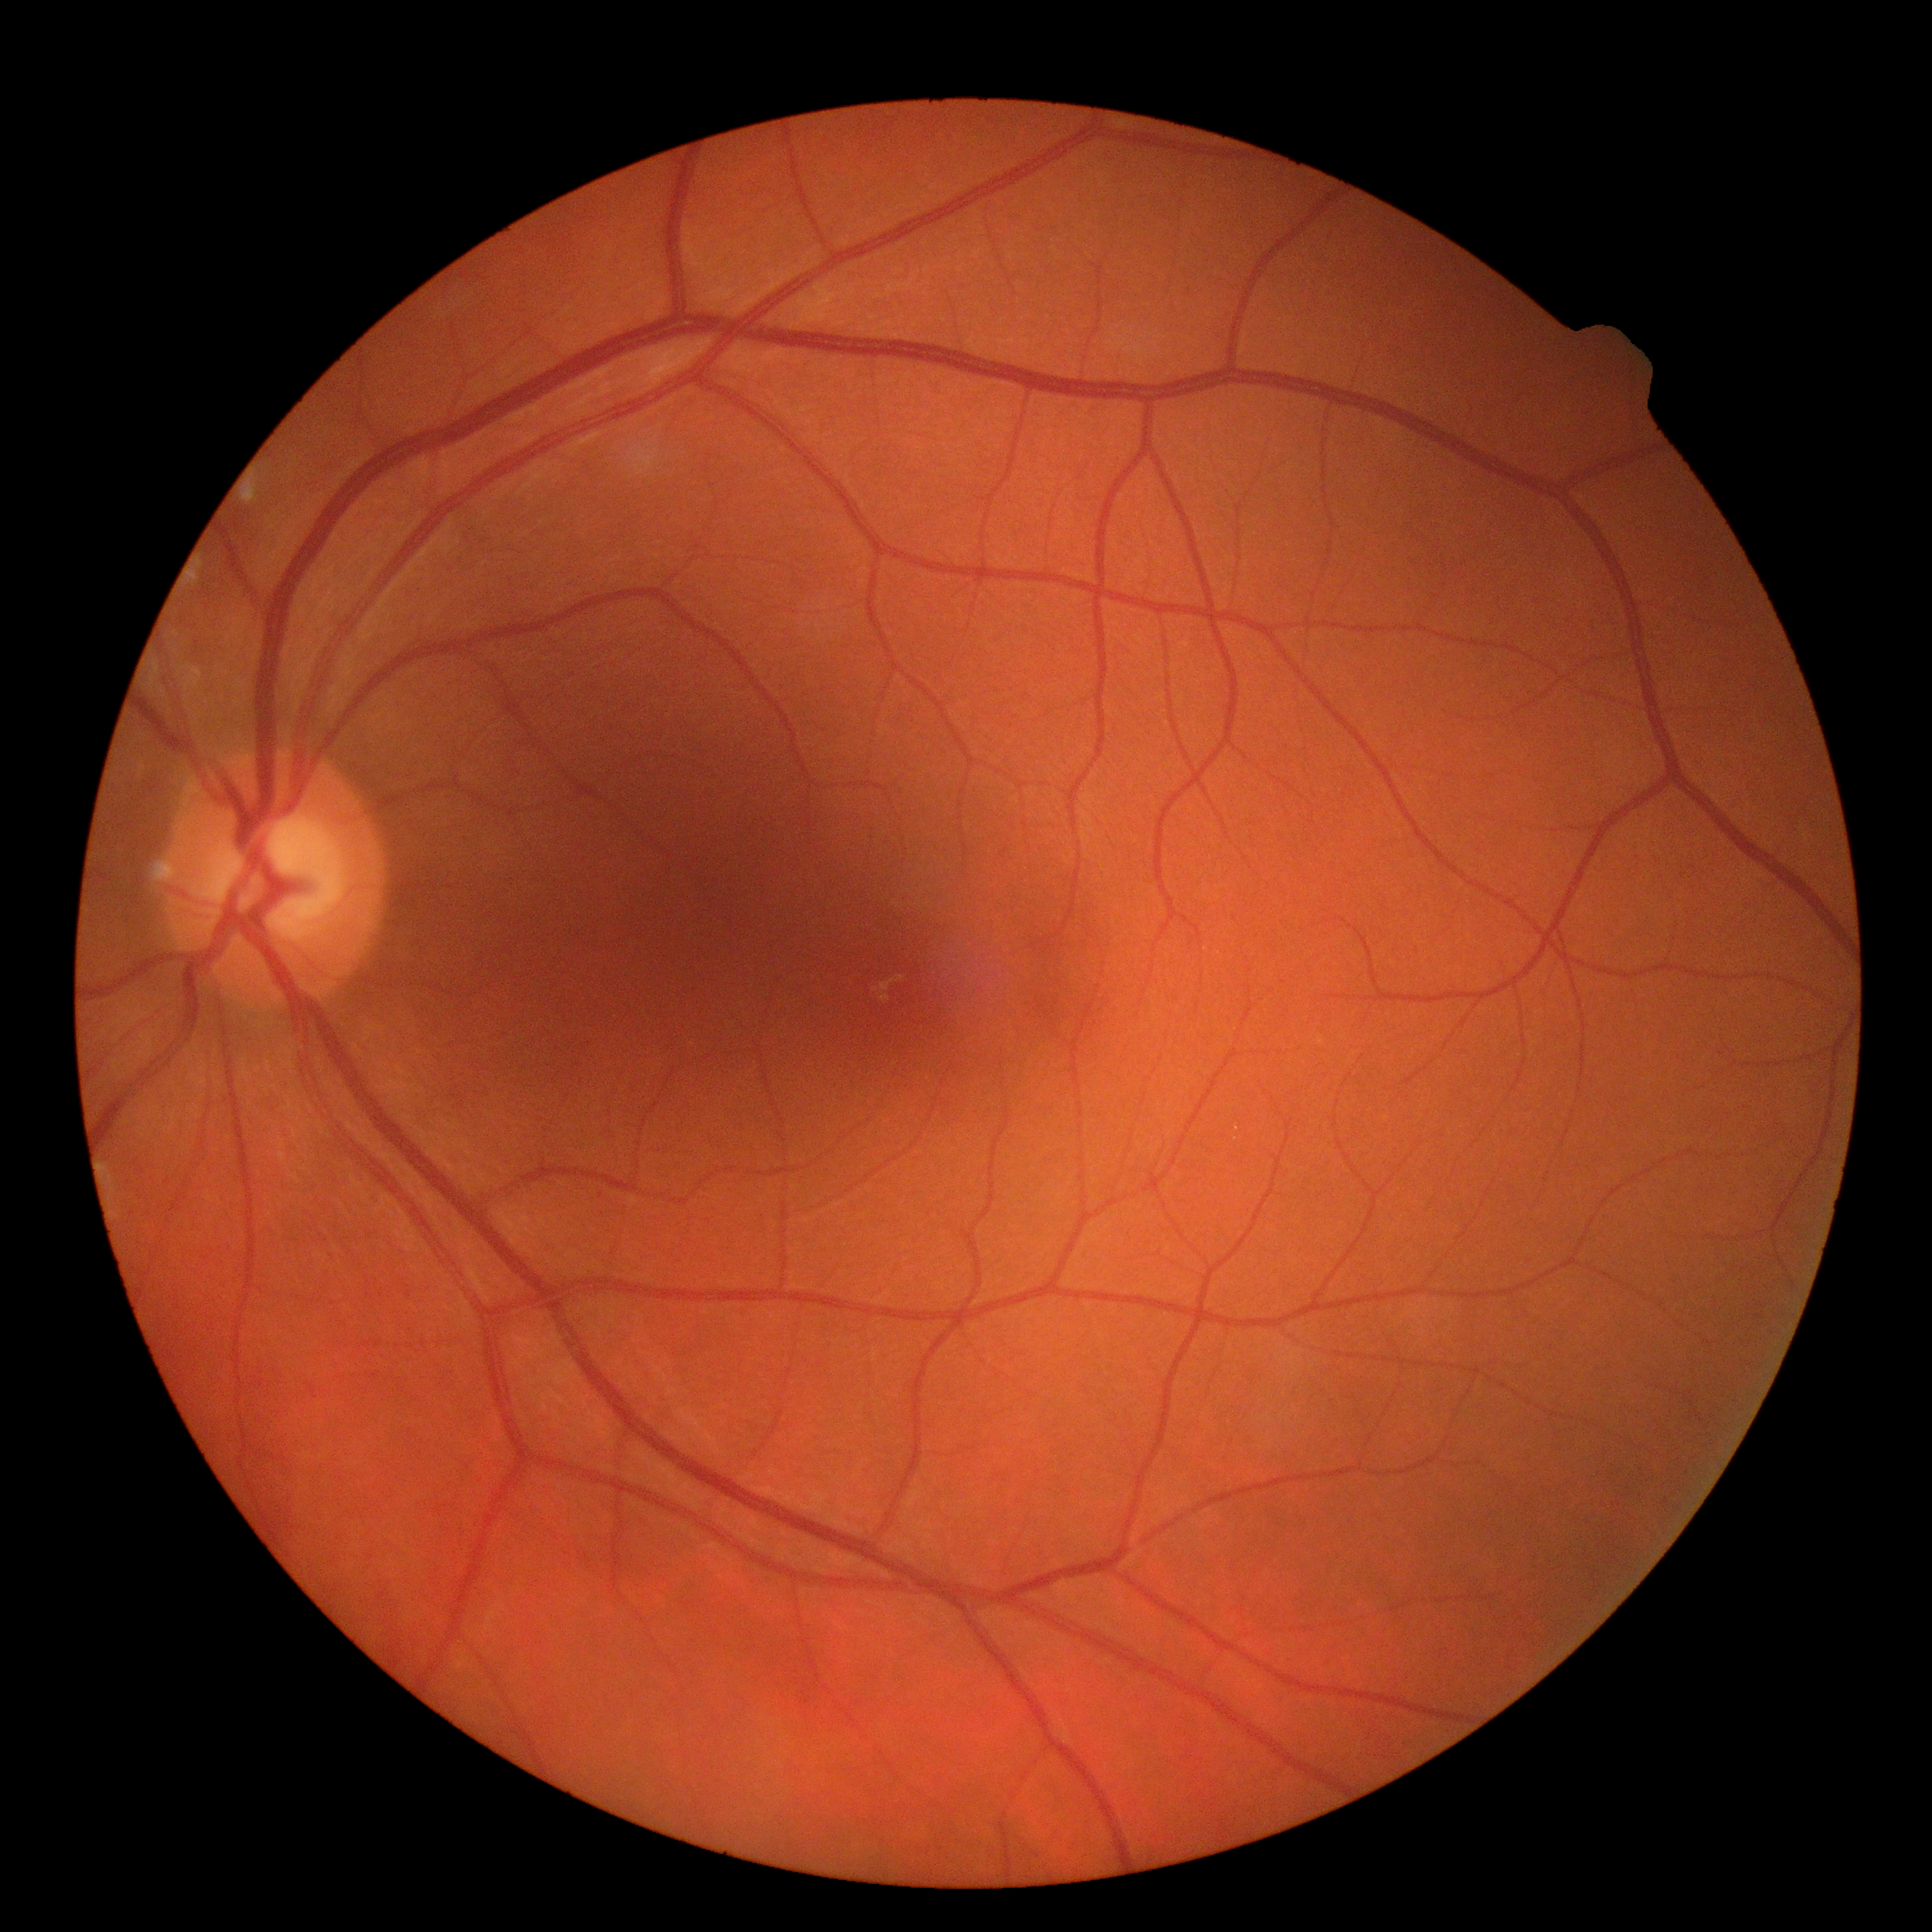 Diabetic retinopathy (DR) is no apparent diabetic retinopathy (grade 0).